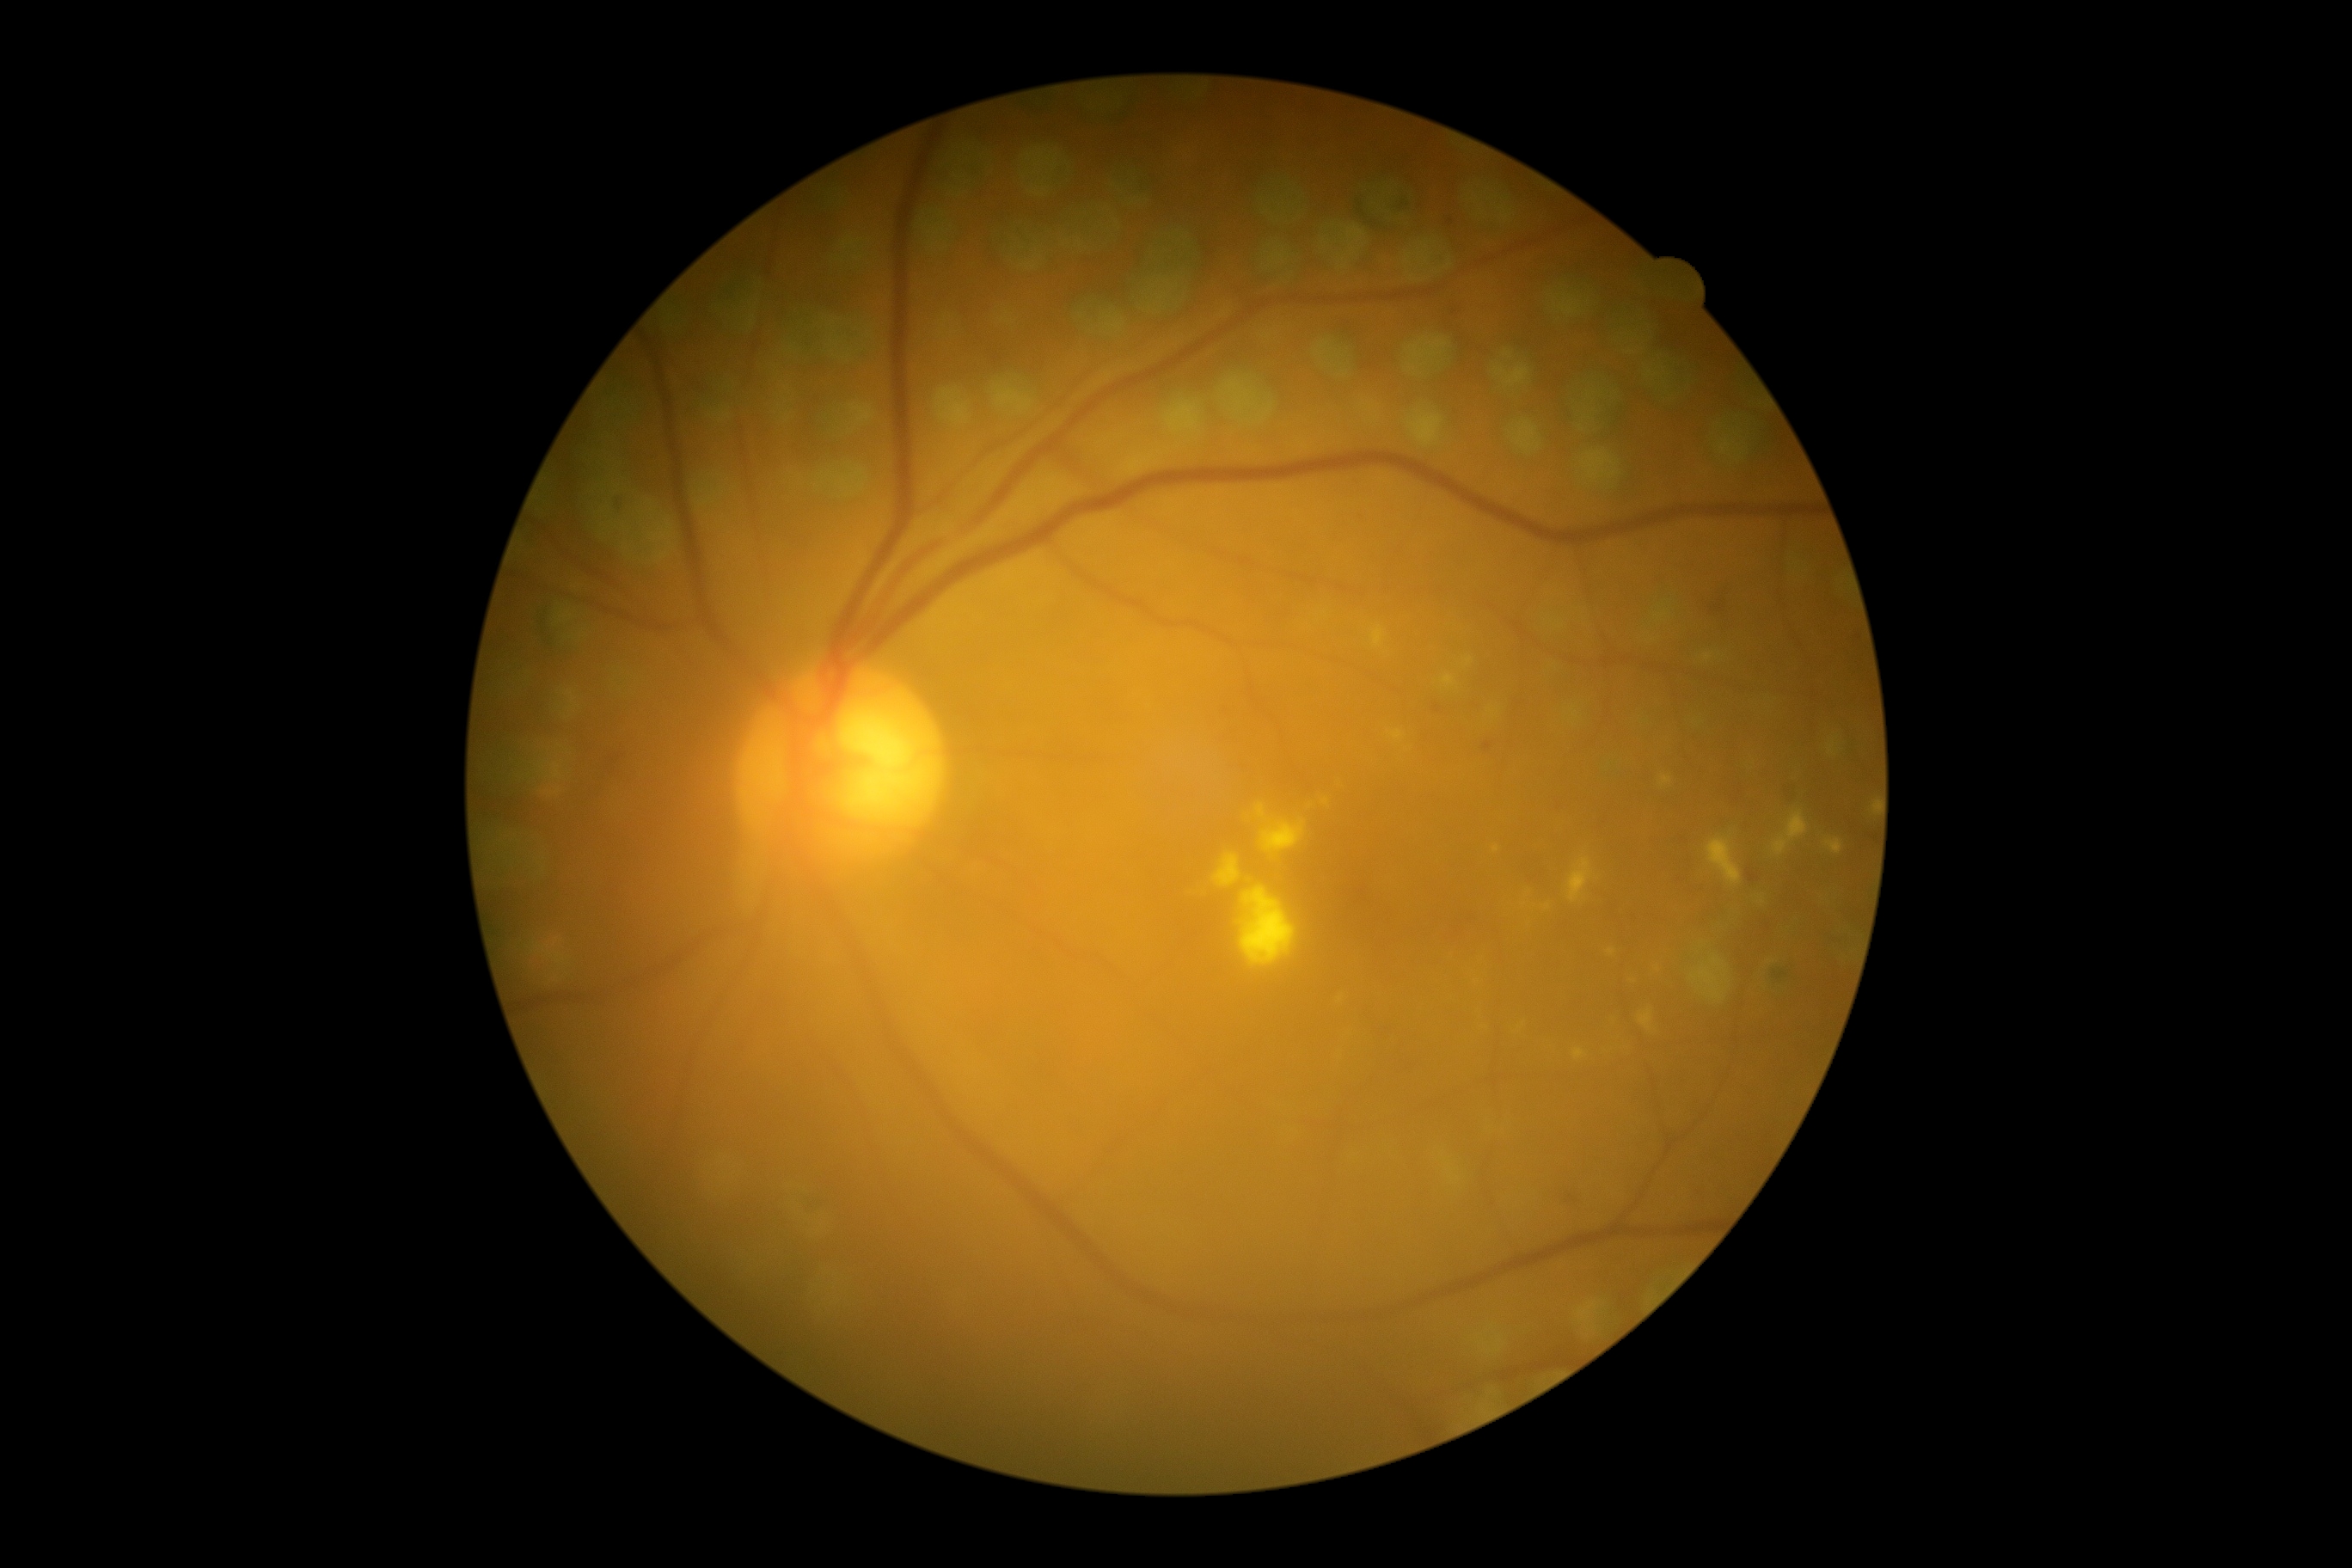
DR class@non-proliferative diabetic retinopathy; DR grade@2 (moderate NPDR).